Acquired with a NIDEK AFC-230.
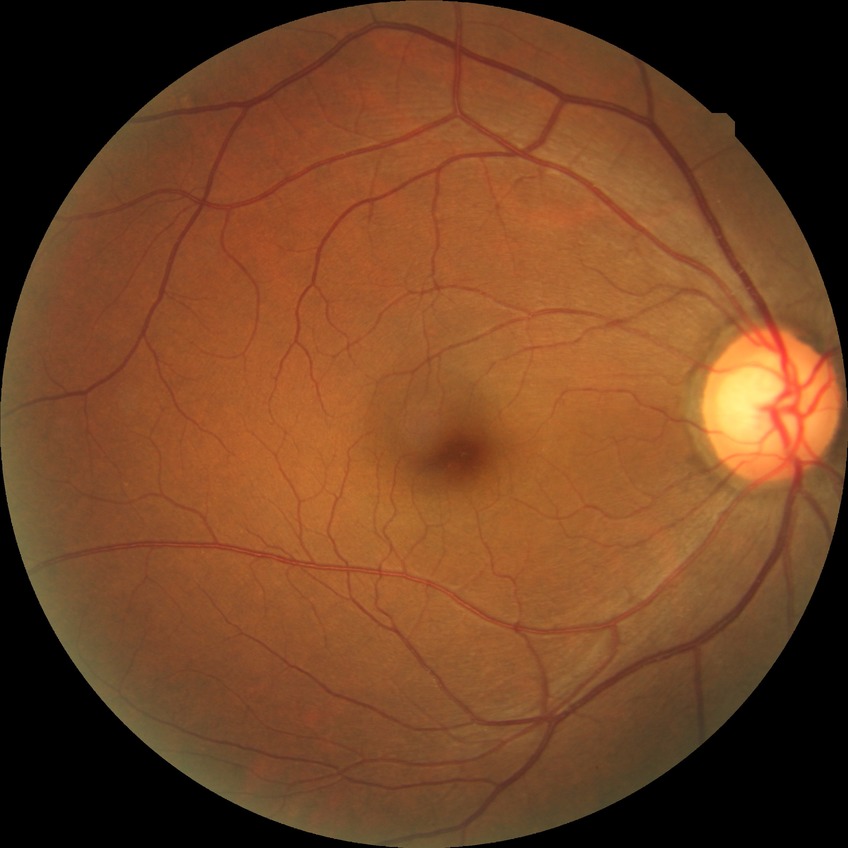
modified Davis grading: no diabetic retinopathy.